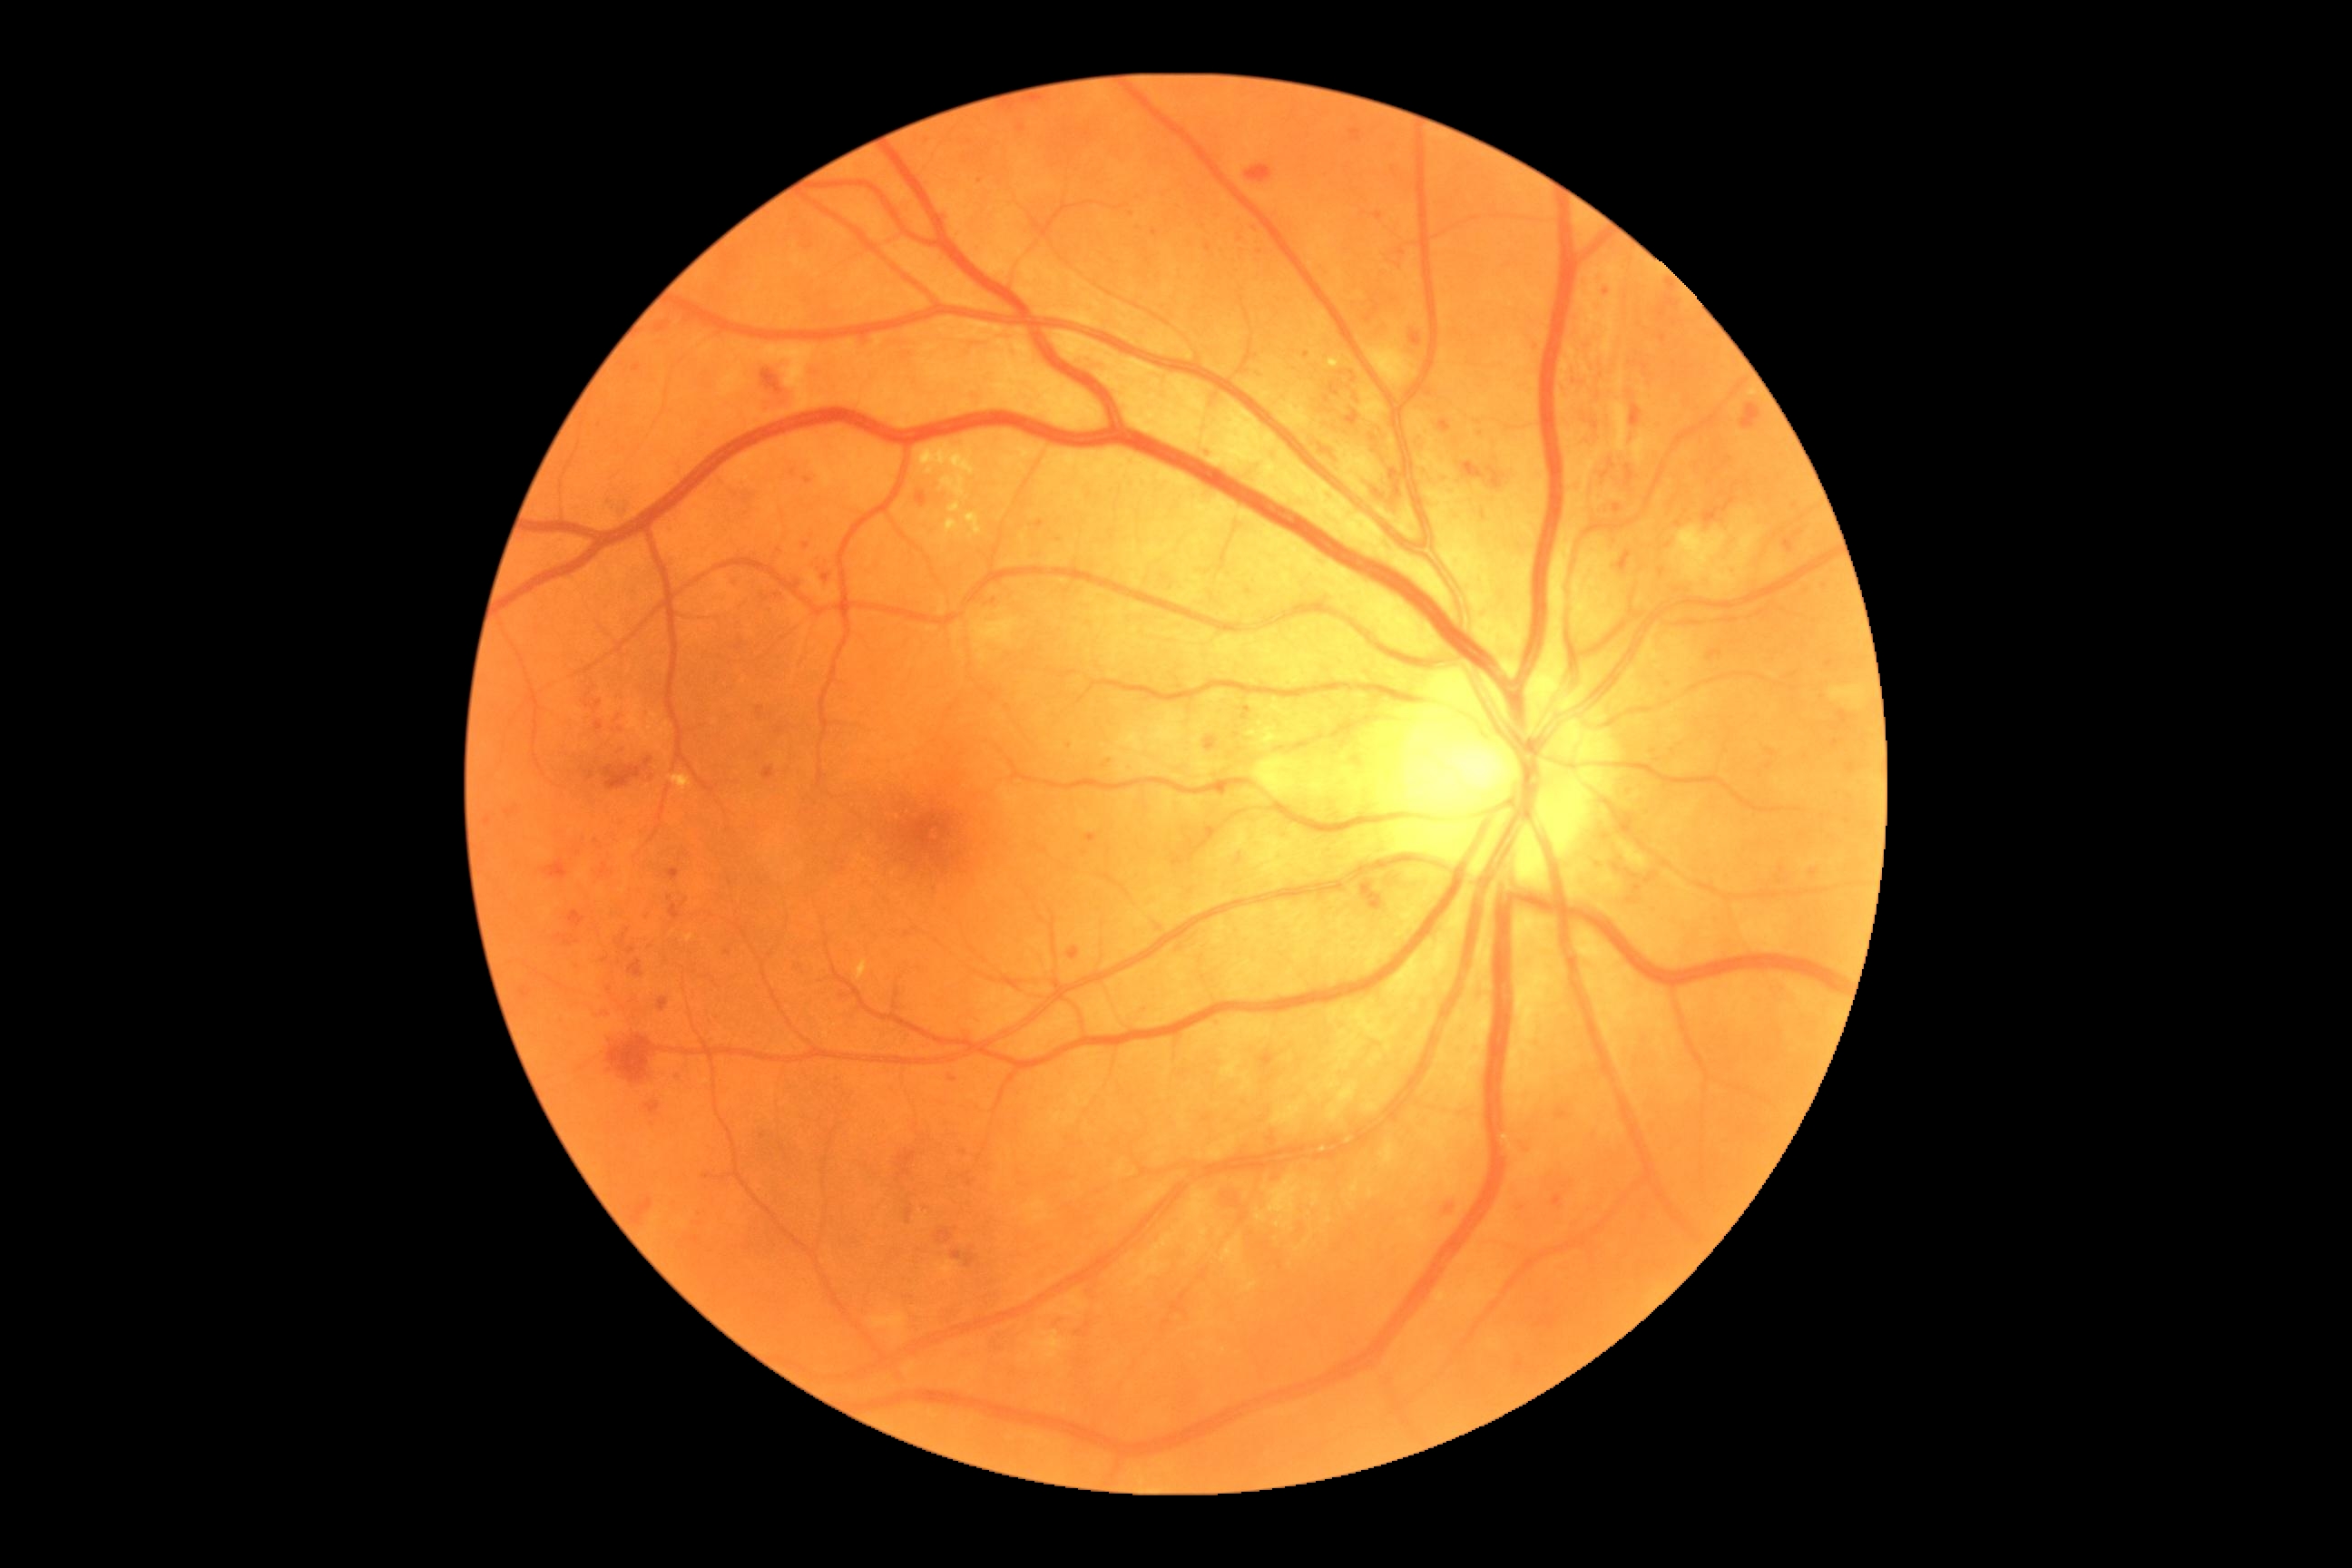 DR stage is severe NPDR (grade 3); non-proliferative diabetic retinopathy
A subset of detected lesions:
HEs (partial): Rect(1349, 130, 1362, 142); Rect(1847, 765, 1856, 774); Rect(1246, 166, 1273, 184); Rect(965, 1255, 975, 1268); Rect(593, 1008, 612, 1017); Rect(569, 912, 585, 928); Rect(605, 765, 642, 790); Rect(672, 1075, 683, 1084); Rect(856, 335, 868, 344); Rect(632, 1199, 652, 1226); Rect(1514, 1142, 1531, 1153); Rect(937, 1230, 952, 1244); Rect(952, 1250, 963, 1260); Rect(1366, 306, 1378, 322); Rect(1618, 551, 1632, 573); Rect(656, 322, 671, 333); Rect(609, 1035, 662, 1084); Rect(1839, 710, 1848, 725); Rect(627, 948, 636, 956)
HEs (small, approximate centers) near 488/821
MAs (partial): Rect(632, 364, 642, 373); Rect(1375, 213, 1384, 220); Rect(667, 868, 680, 881); Rect(674, 1073, 681, 1081)
MAs (small, approximate centers) near 1244/718; 1782/870; 1154/234; 806/546; 1482/434; 964/1153; 1208/247; 580/965; 734/581; 980/181; 837/1080; 1537/347; 1830/665; 1770/767
EXs (partial): Rect(685, 934, 694, 943); Rect(856, 959, 868, 981); Rect(921, 447, 930, 460); Rect(1329, 358, 1342, 369); Rect(1248, 730, 1259, 736); Rect(1257, 729, 1280, 747); Rect(965, 513, 983, 536); Rect(939, 473, 968, 495); Rect(934, 444, 943, 460); Rect(965, 447, 970, 466); Rect(948, 502, 961, 514); Rect(925, 466, 934, 475); Rect(948, 447, 957, 462); Rect(941, 520, 959, 544); Rect(669, 776, 692, 792)
EXs (small, approximate centers) near 971/537; 1261/724
SEs: Rect(1672, 525, 1765, 591); Rect(761, 346, 827, 411); Rect(1253, 756, 1279, 798); Rect(1364, 333, 1418, 387); Rect(1830, 687, 1865, 709); Rect(970, 618, 1021, 651)